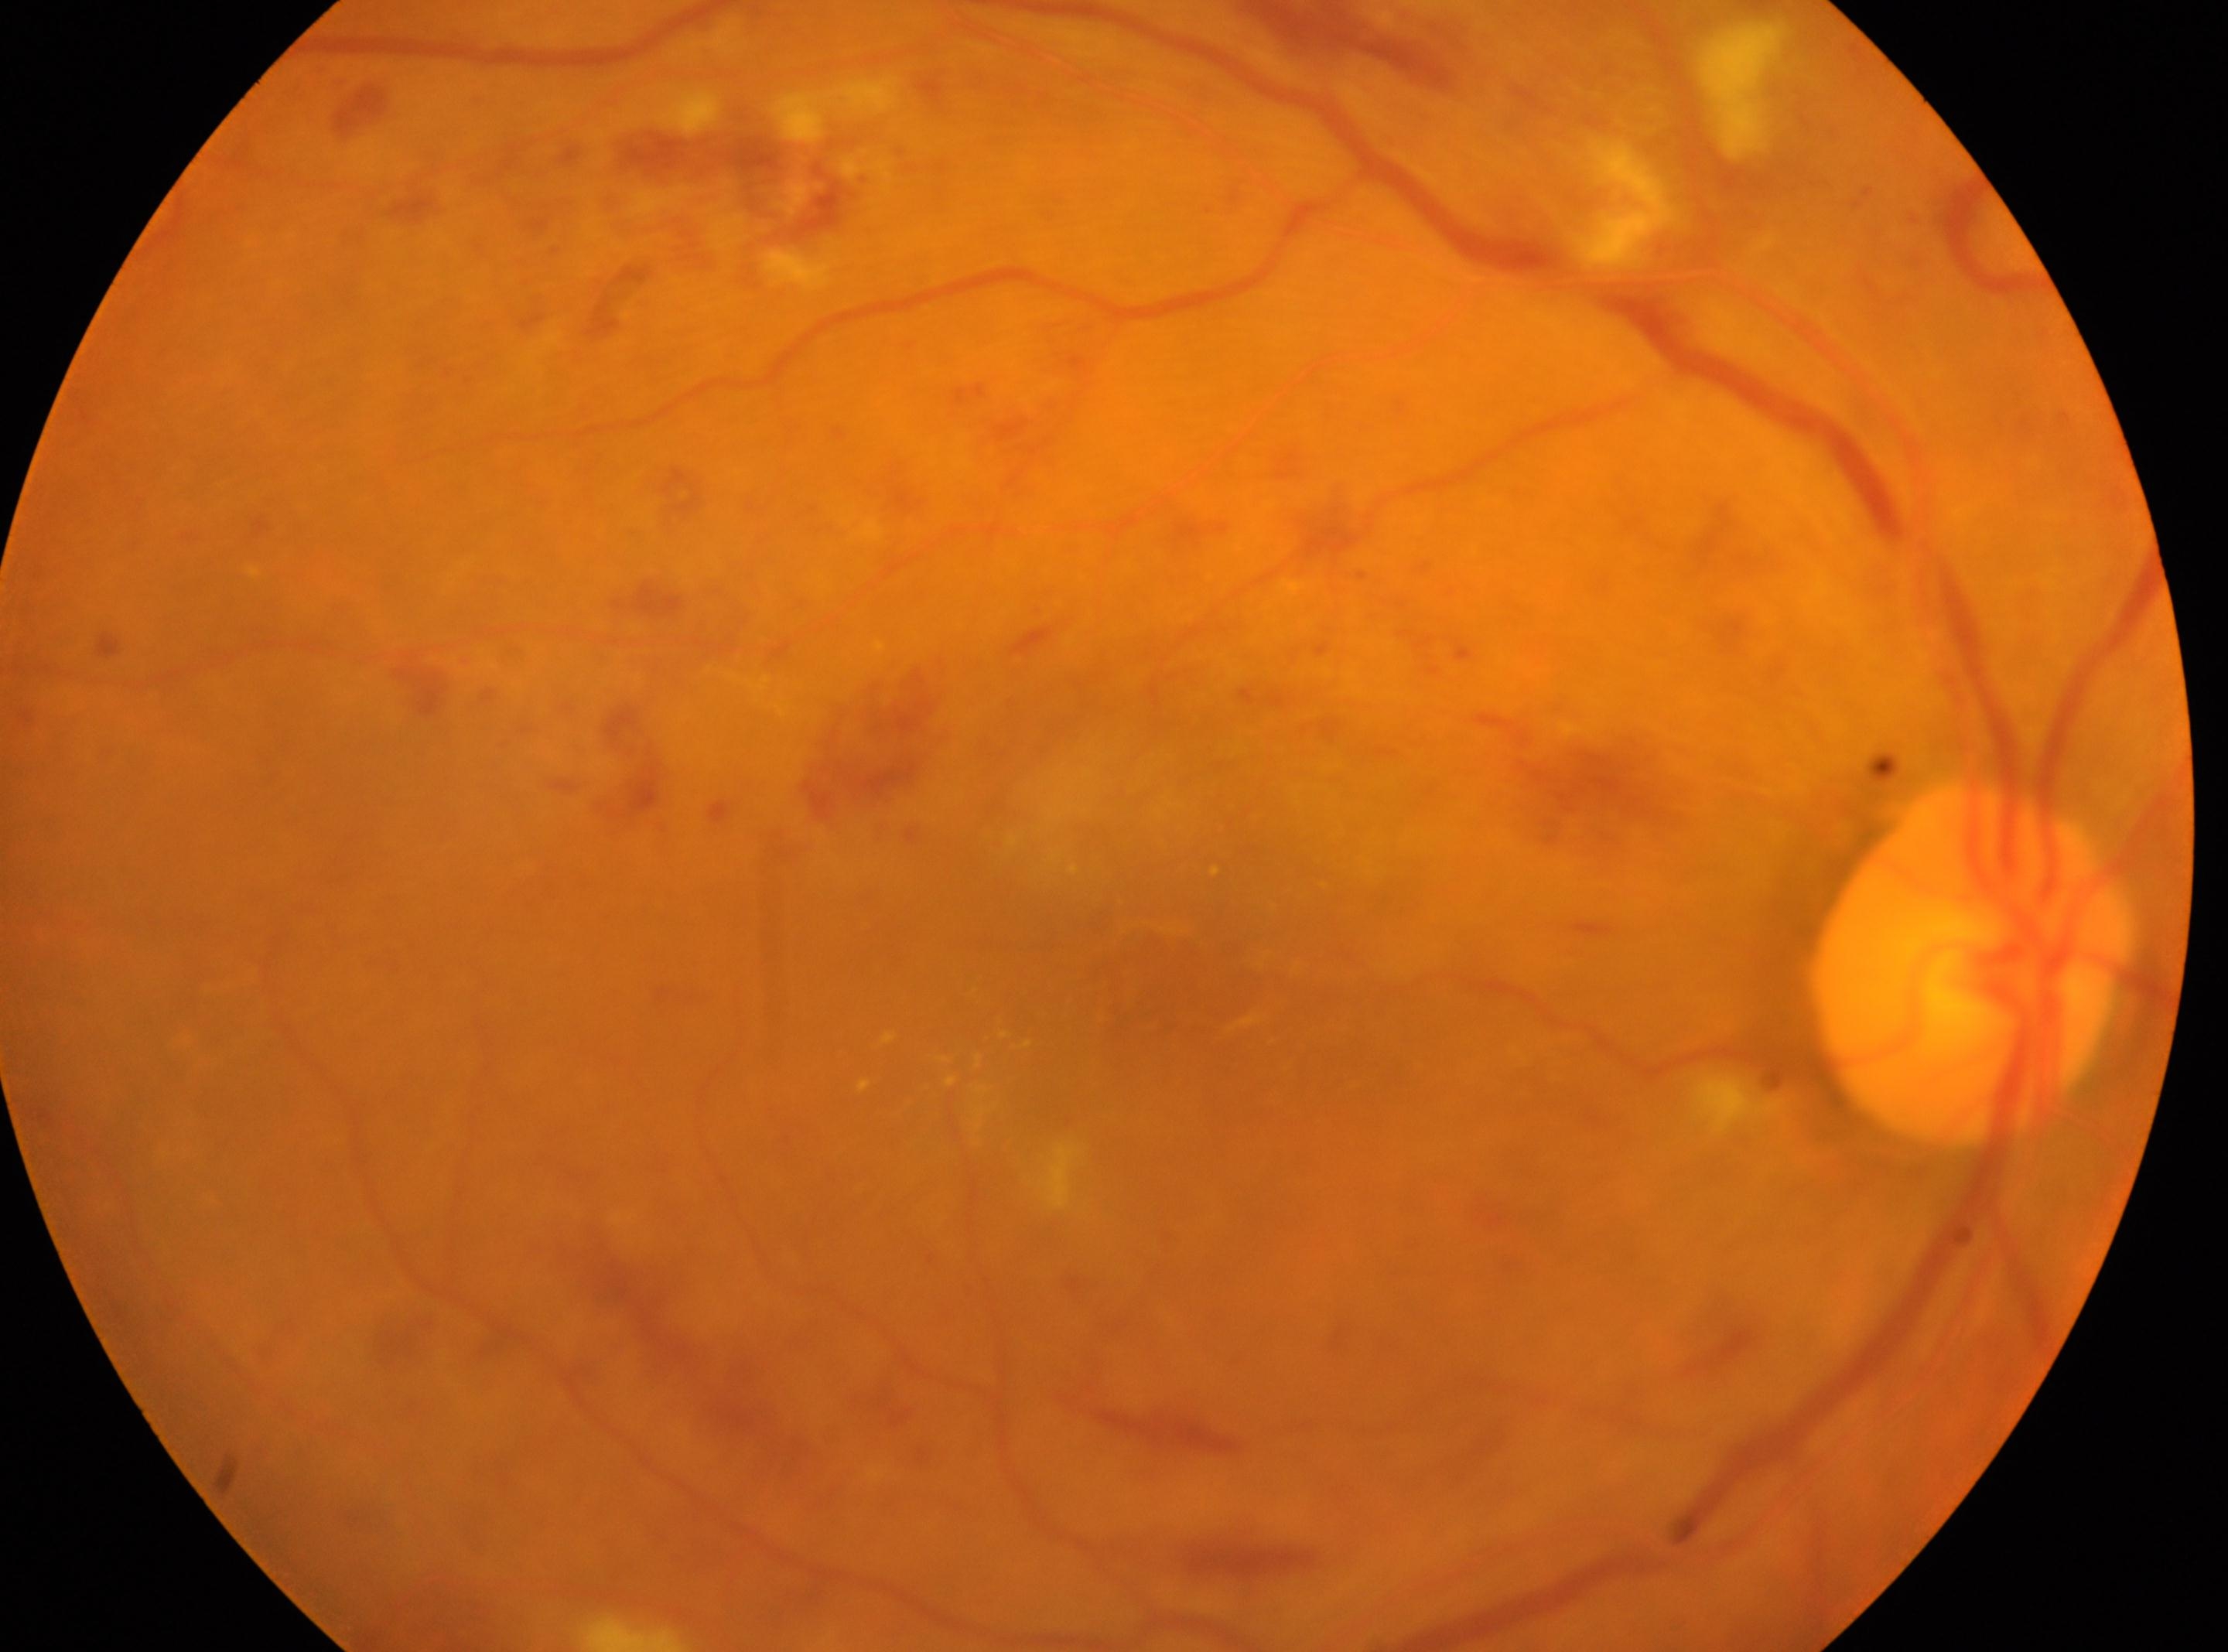 {
  "fovea": "1170px, 978px",
  "dr_category": "non-proliferative diabetic retinopathy",
  "optic_disc": "1970px, 964px",
  "dr_grade": "severe non-proliferative diabetic retinopathy (grade 3)",
  "eye": "the right eye"
}